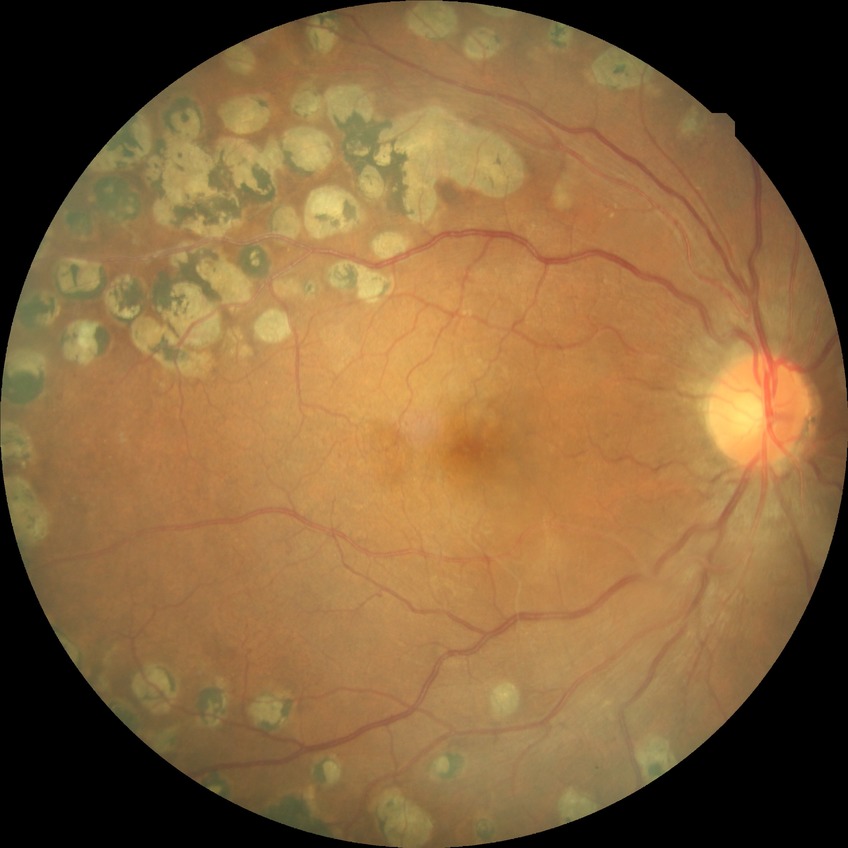
diabetic retinopathy stage = proliferative diabetic retinopathy.